Davis DR grading · 45° FOV · no pharmacologic dilation.
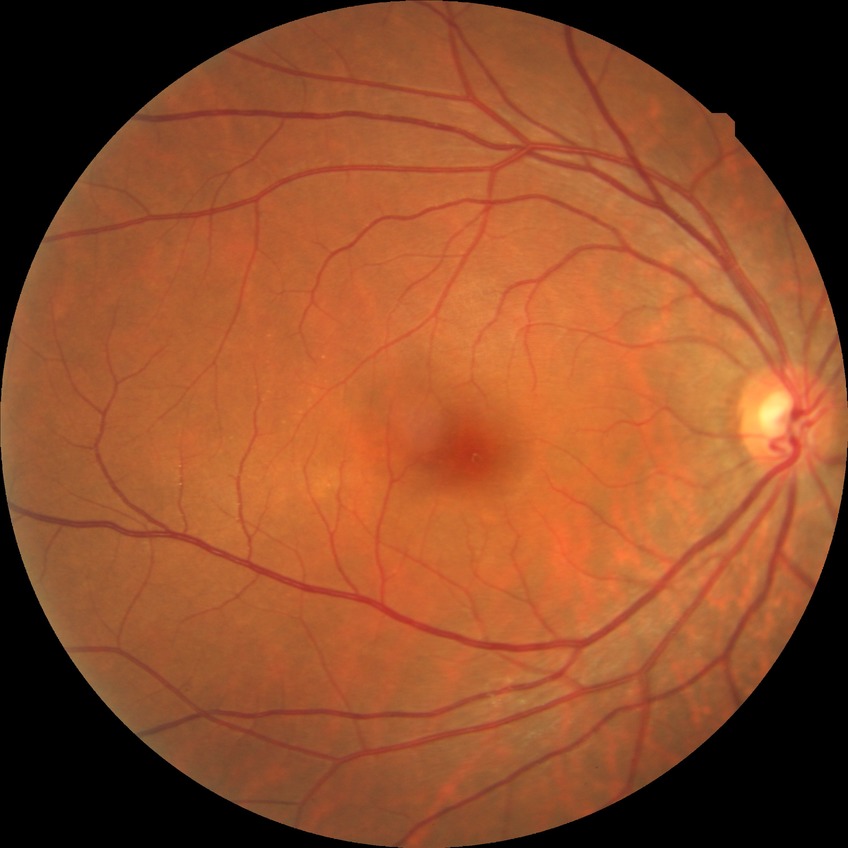 davis_grade: no diabetic retinopathy (NDR)